2048x1536
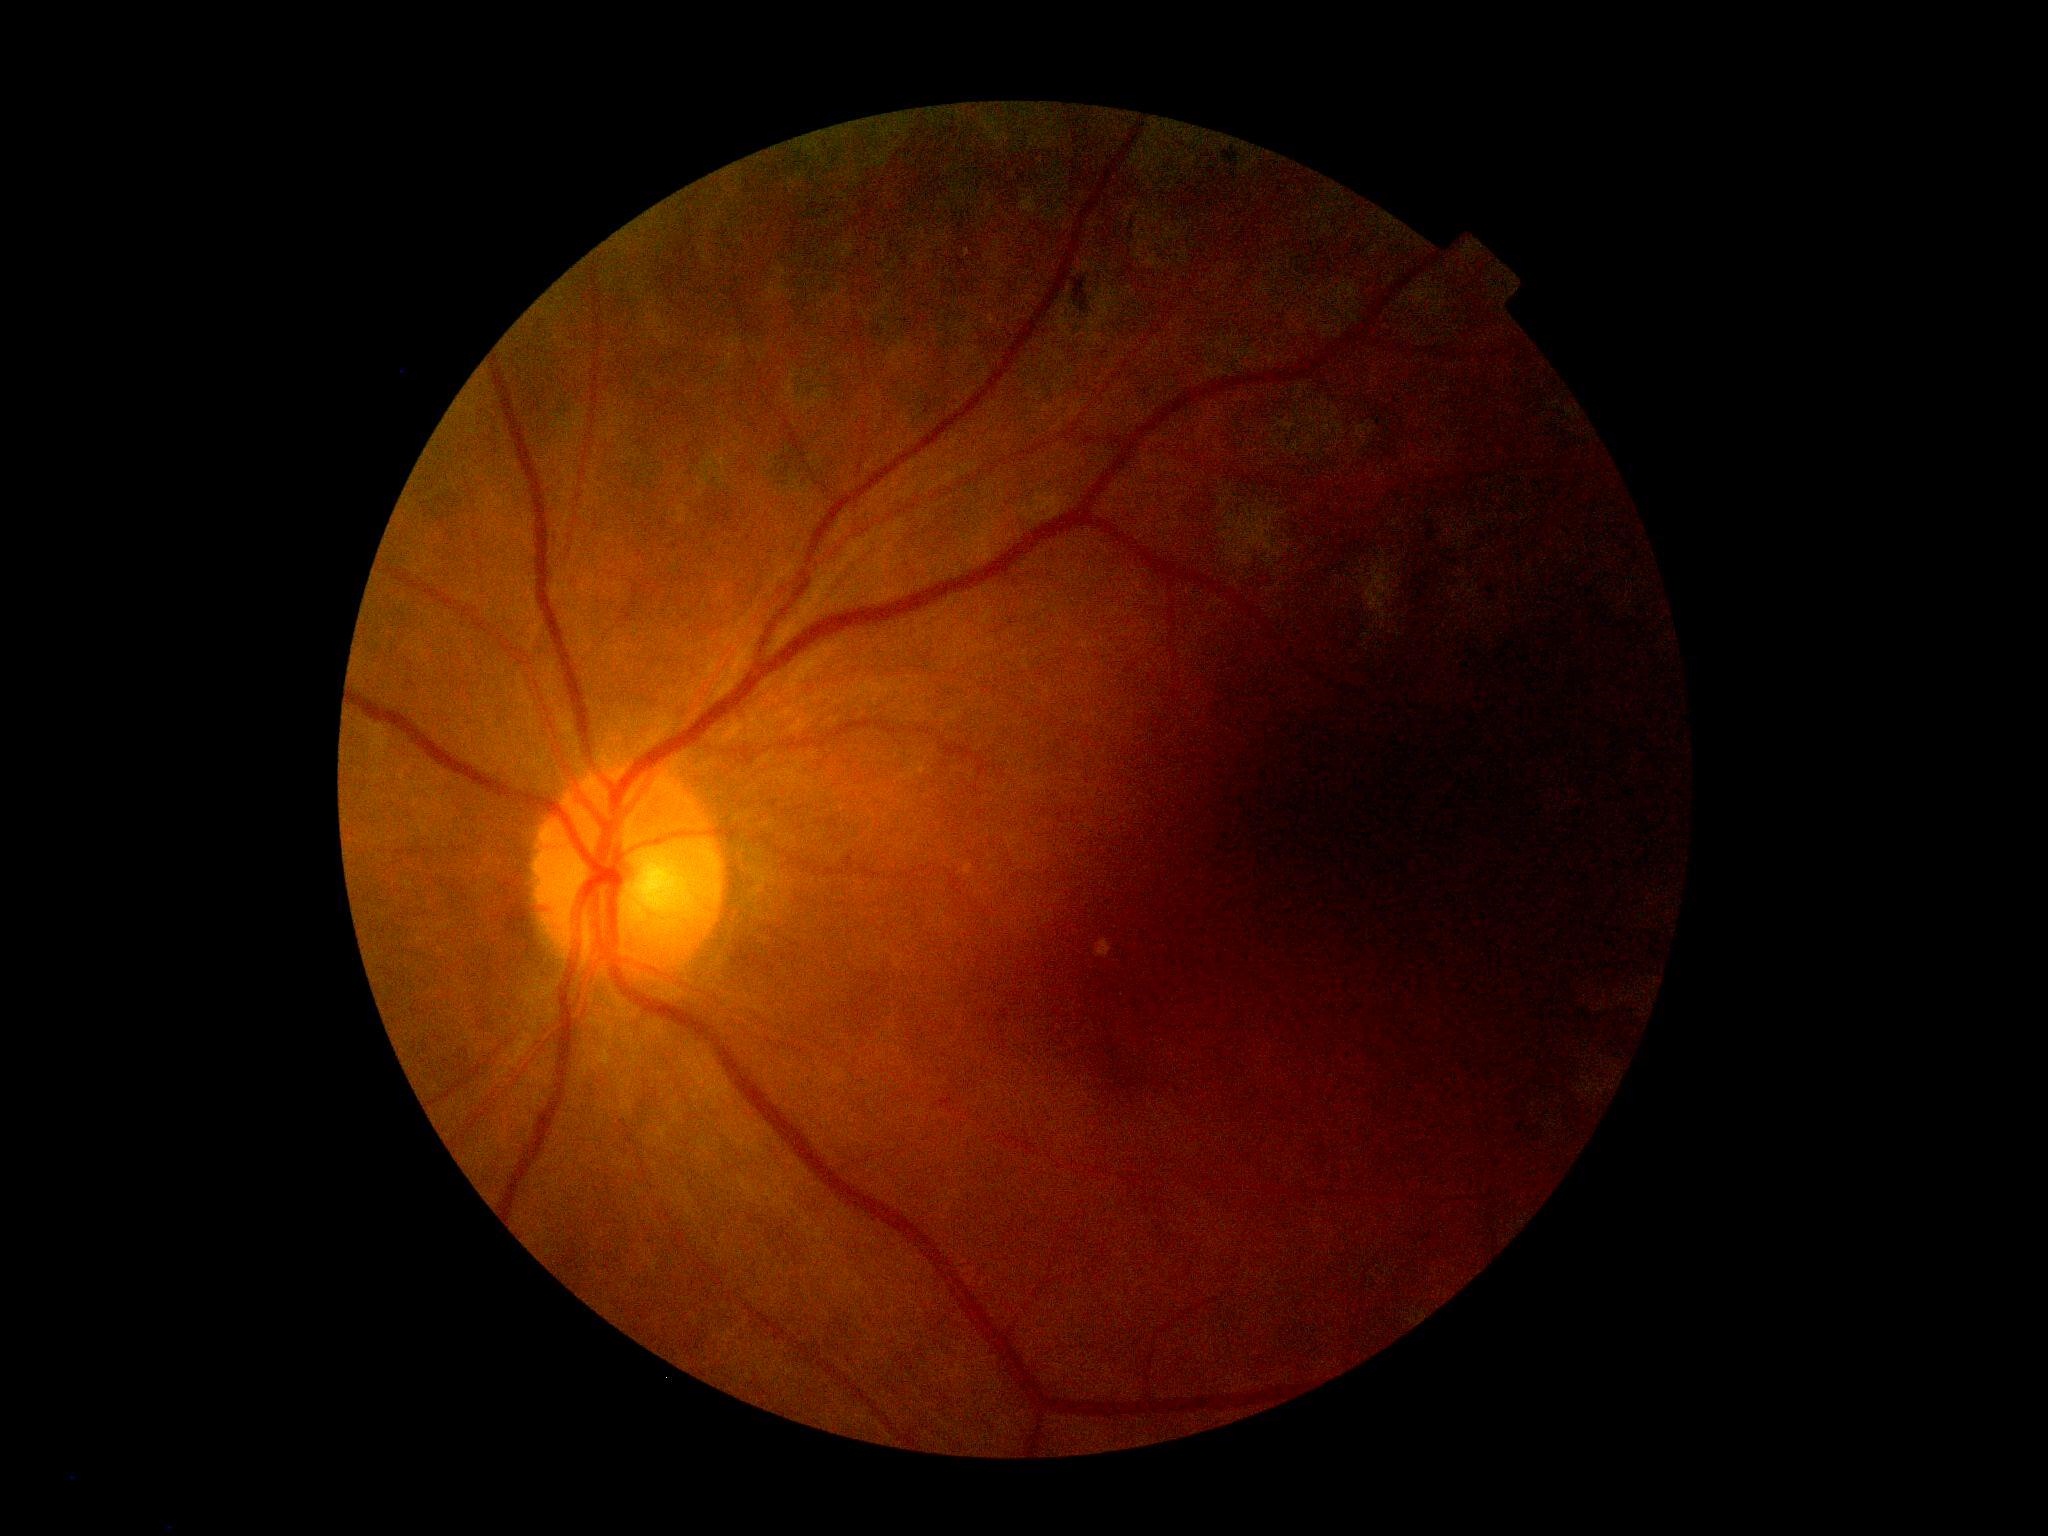

diabetic retinopathy (DR): grade 0 (no apparent retinopathy) — no visible signs of diabetic retinopathy.